45-degree field of view, DR severity per modified Davis staging, 848 by 848 pixels: 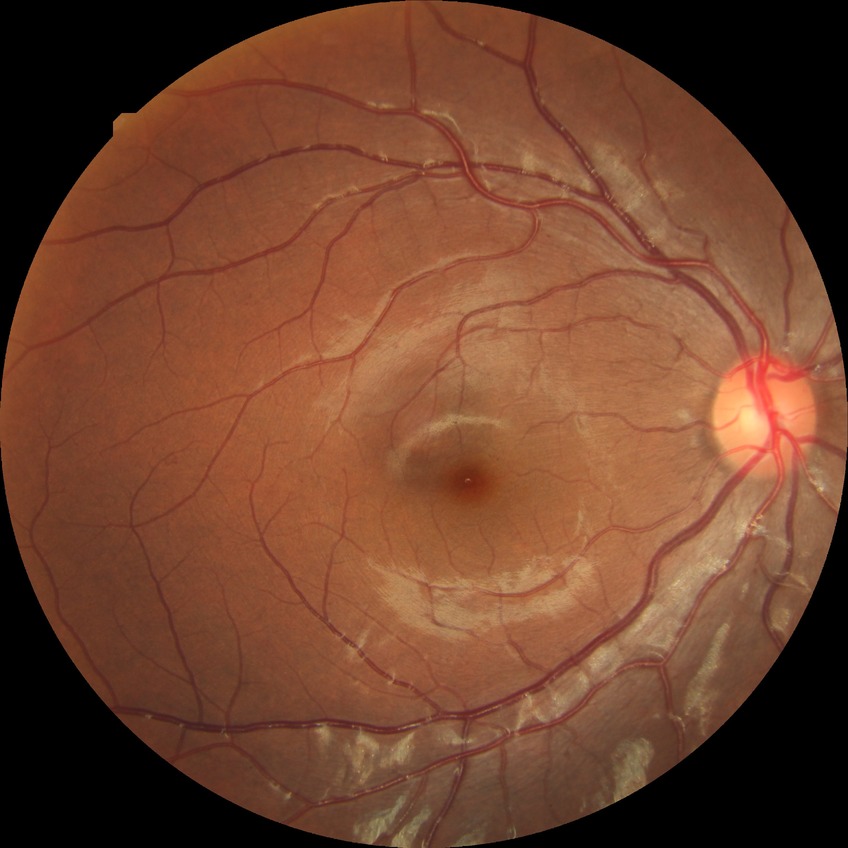 Diabetic retinopathy (DR): simple diabetic retinopathy (SDR).